1240x1240px · wide-field fundus photograph from neonatal ROP screening · captured with the Phoenix ICON (100° field of view): 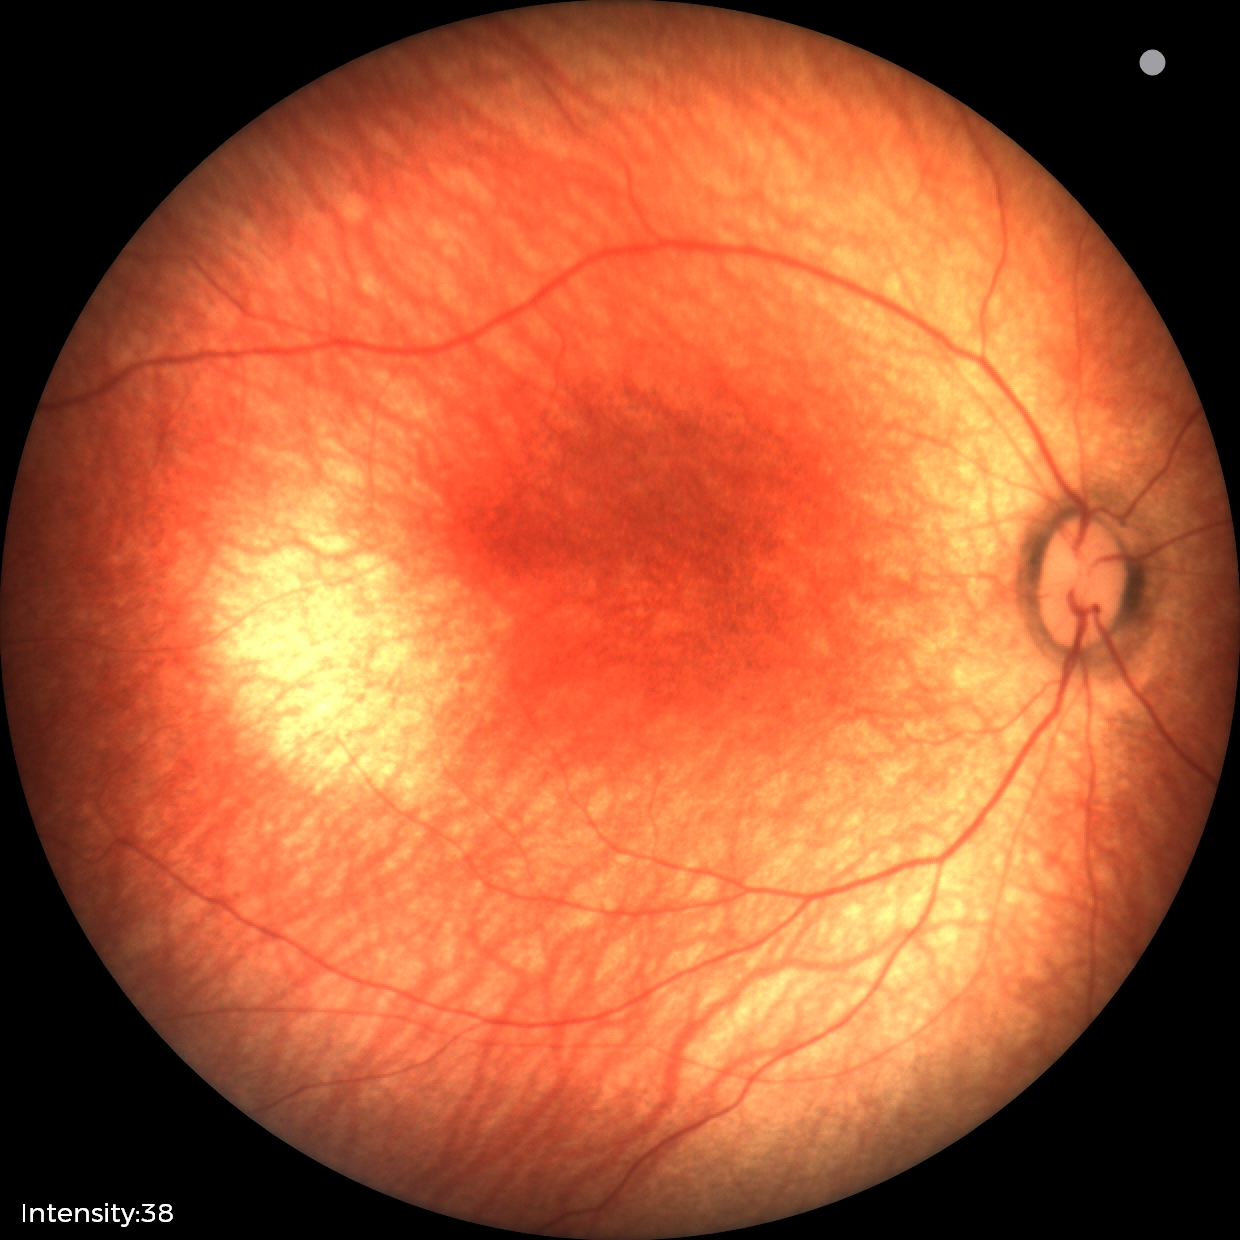

Screening diagnosis = normal retinal appearance.